CFP:
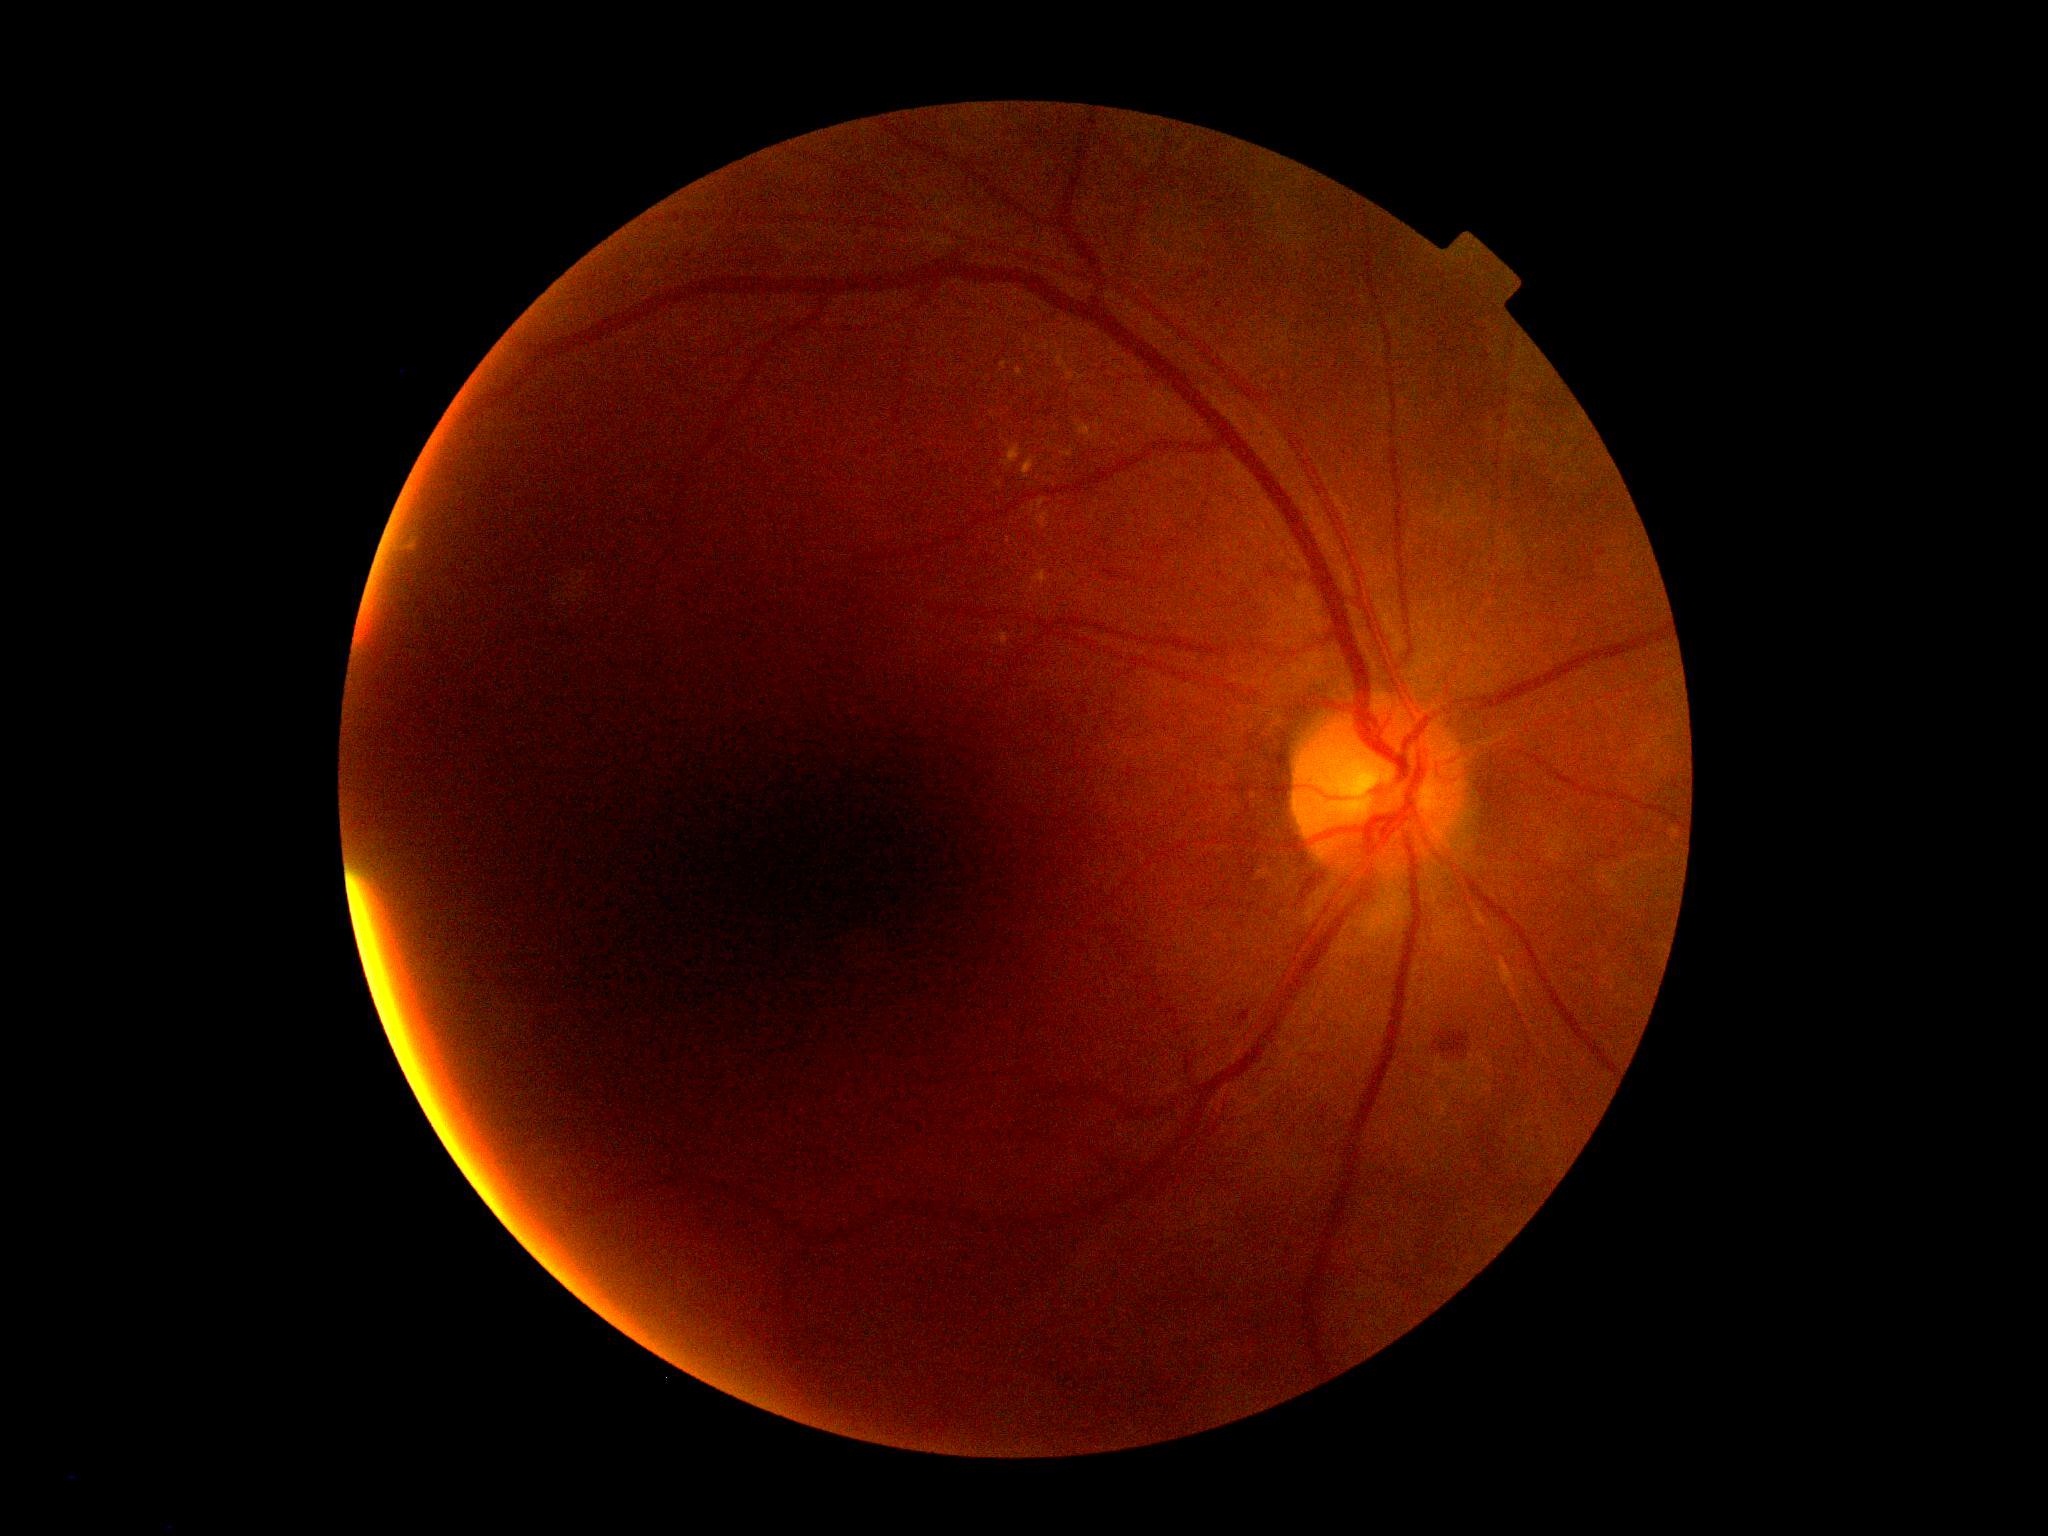 diabetic retinopathy (DR): 2/4.